Acquired with a Topcon TRC-50DX; 50° field of view — 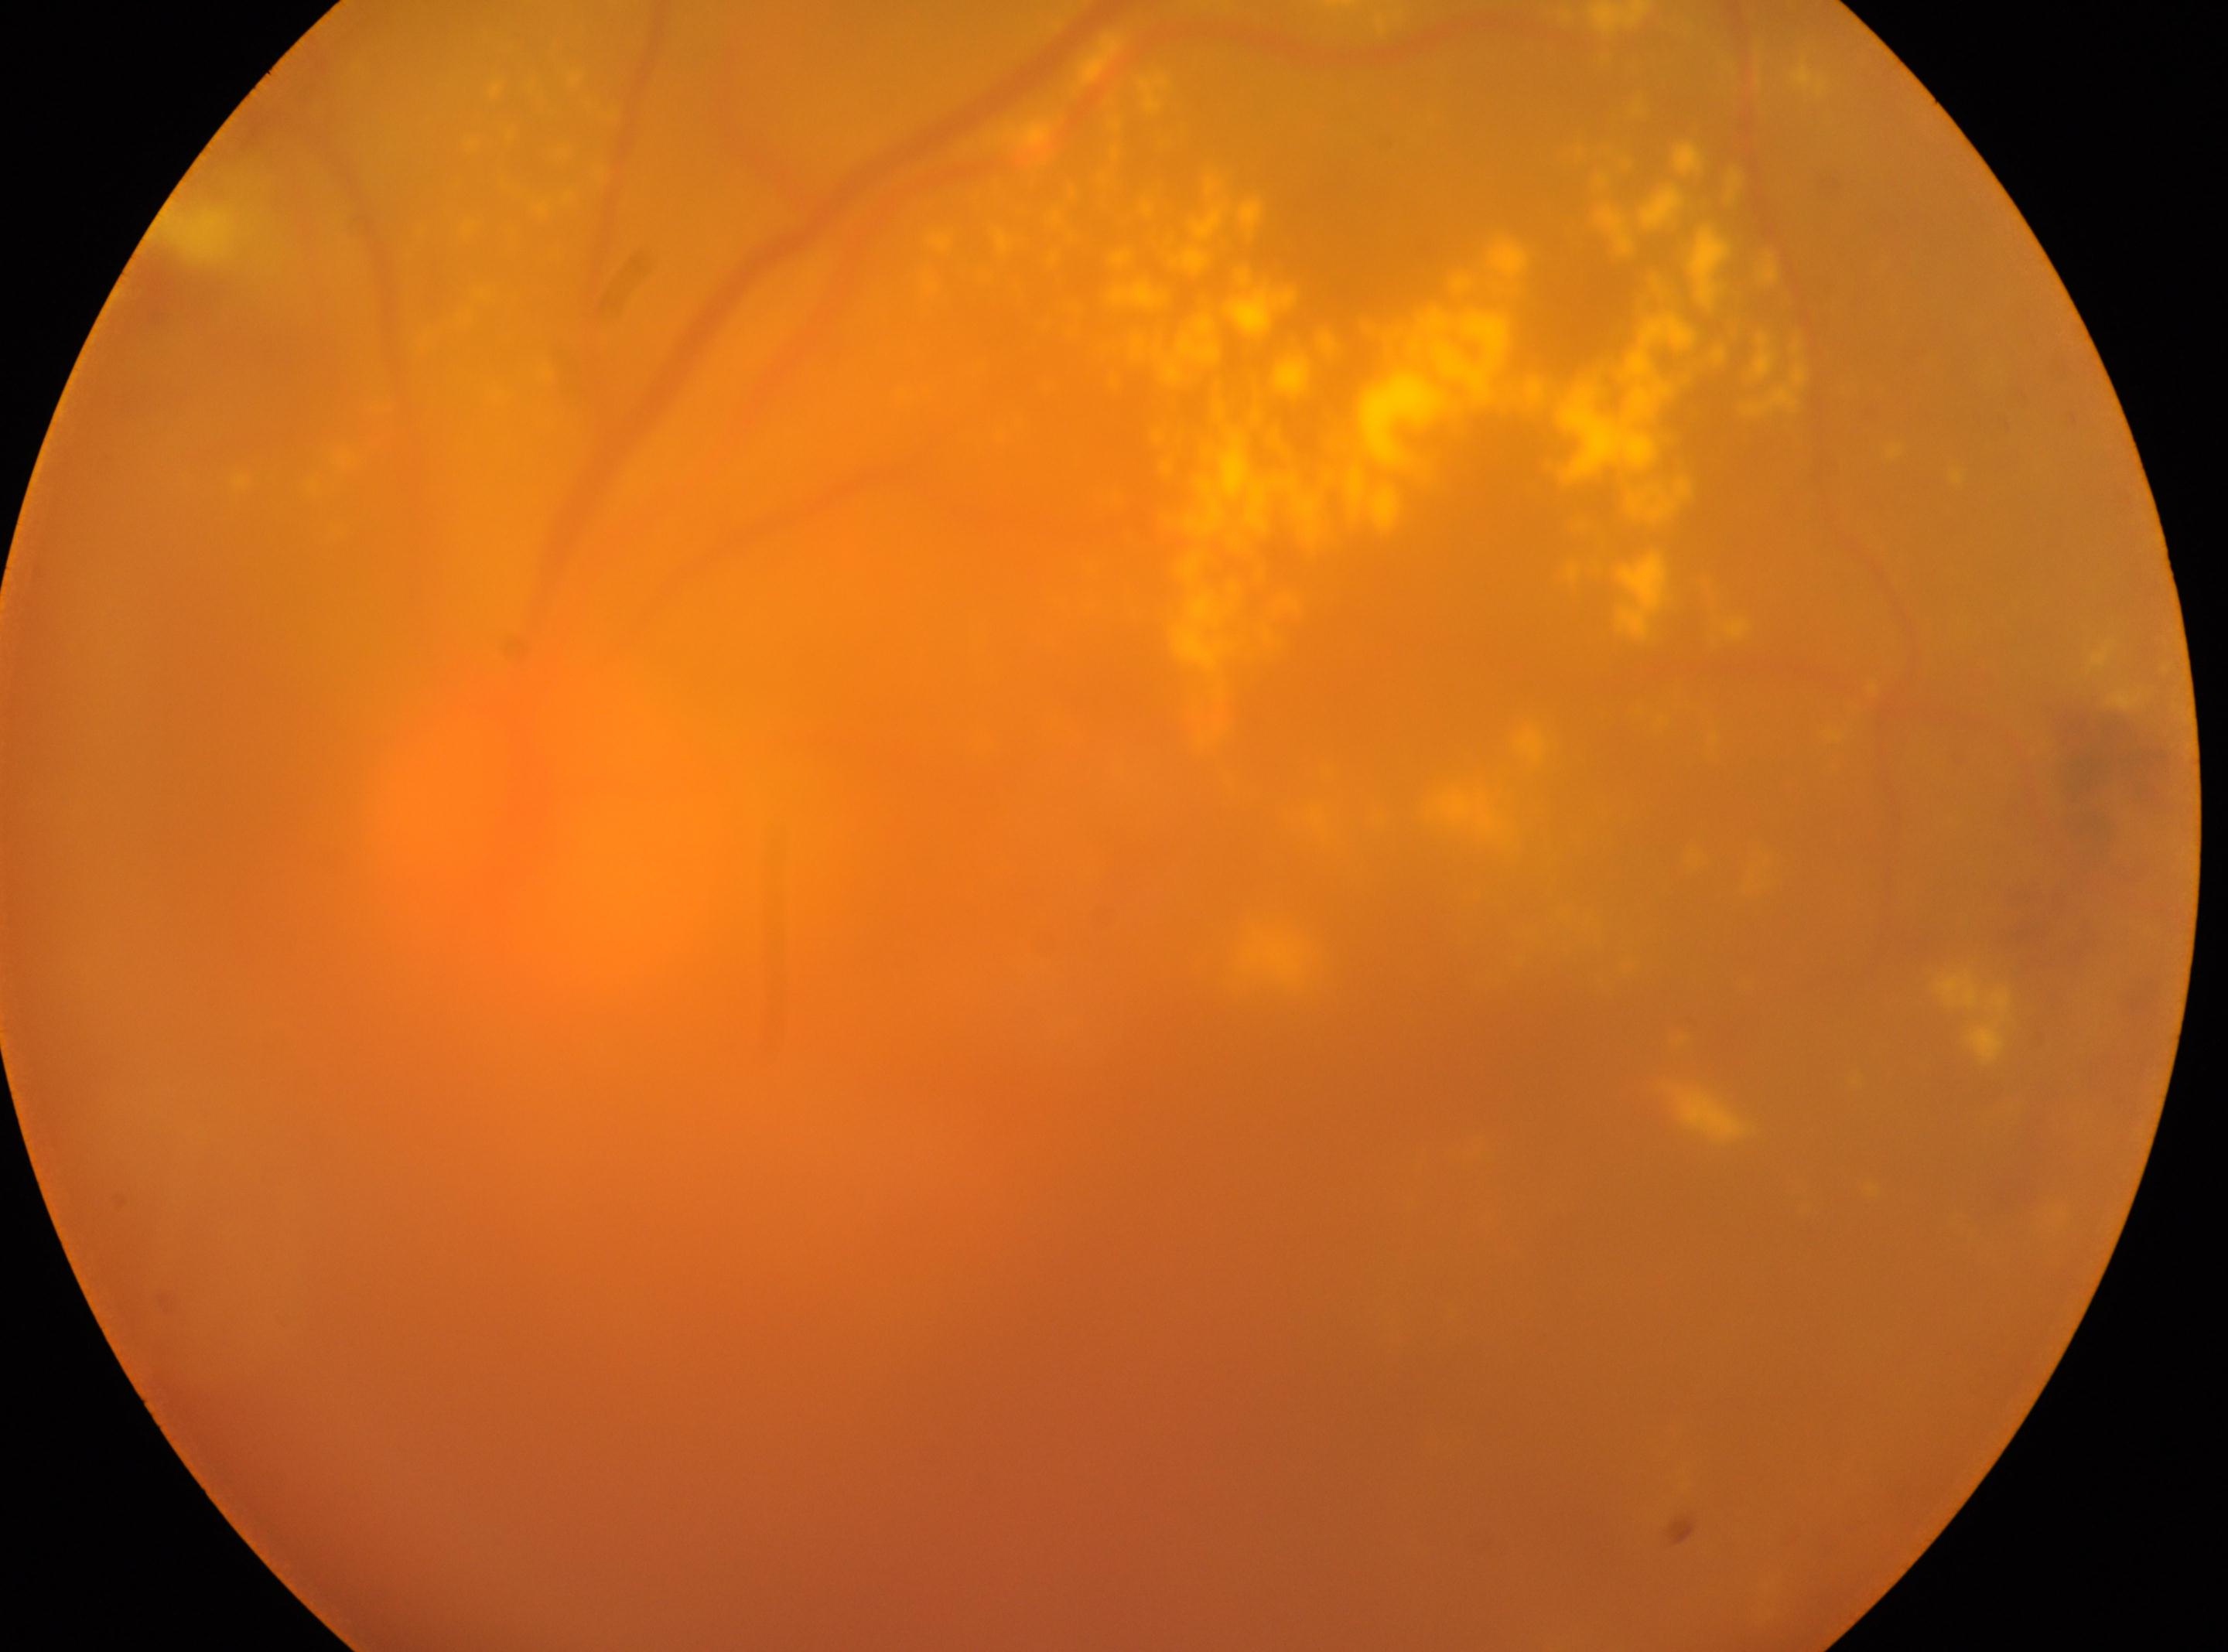

{"fovea": "1374px, 961px", "dr_grade": "2", "optic_disc": "553px, 826px", "eye": "left eye", "dr_category": "non-proliferative diabetic retinopathy"}